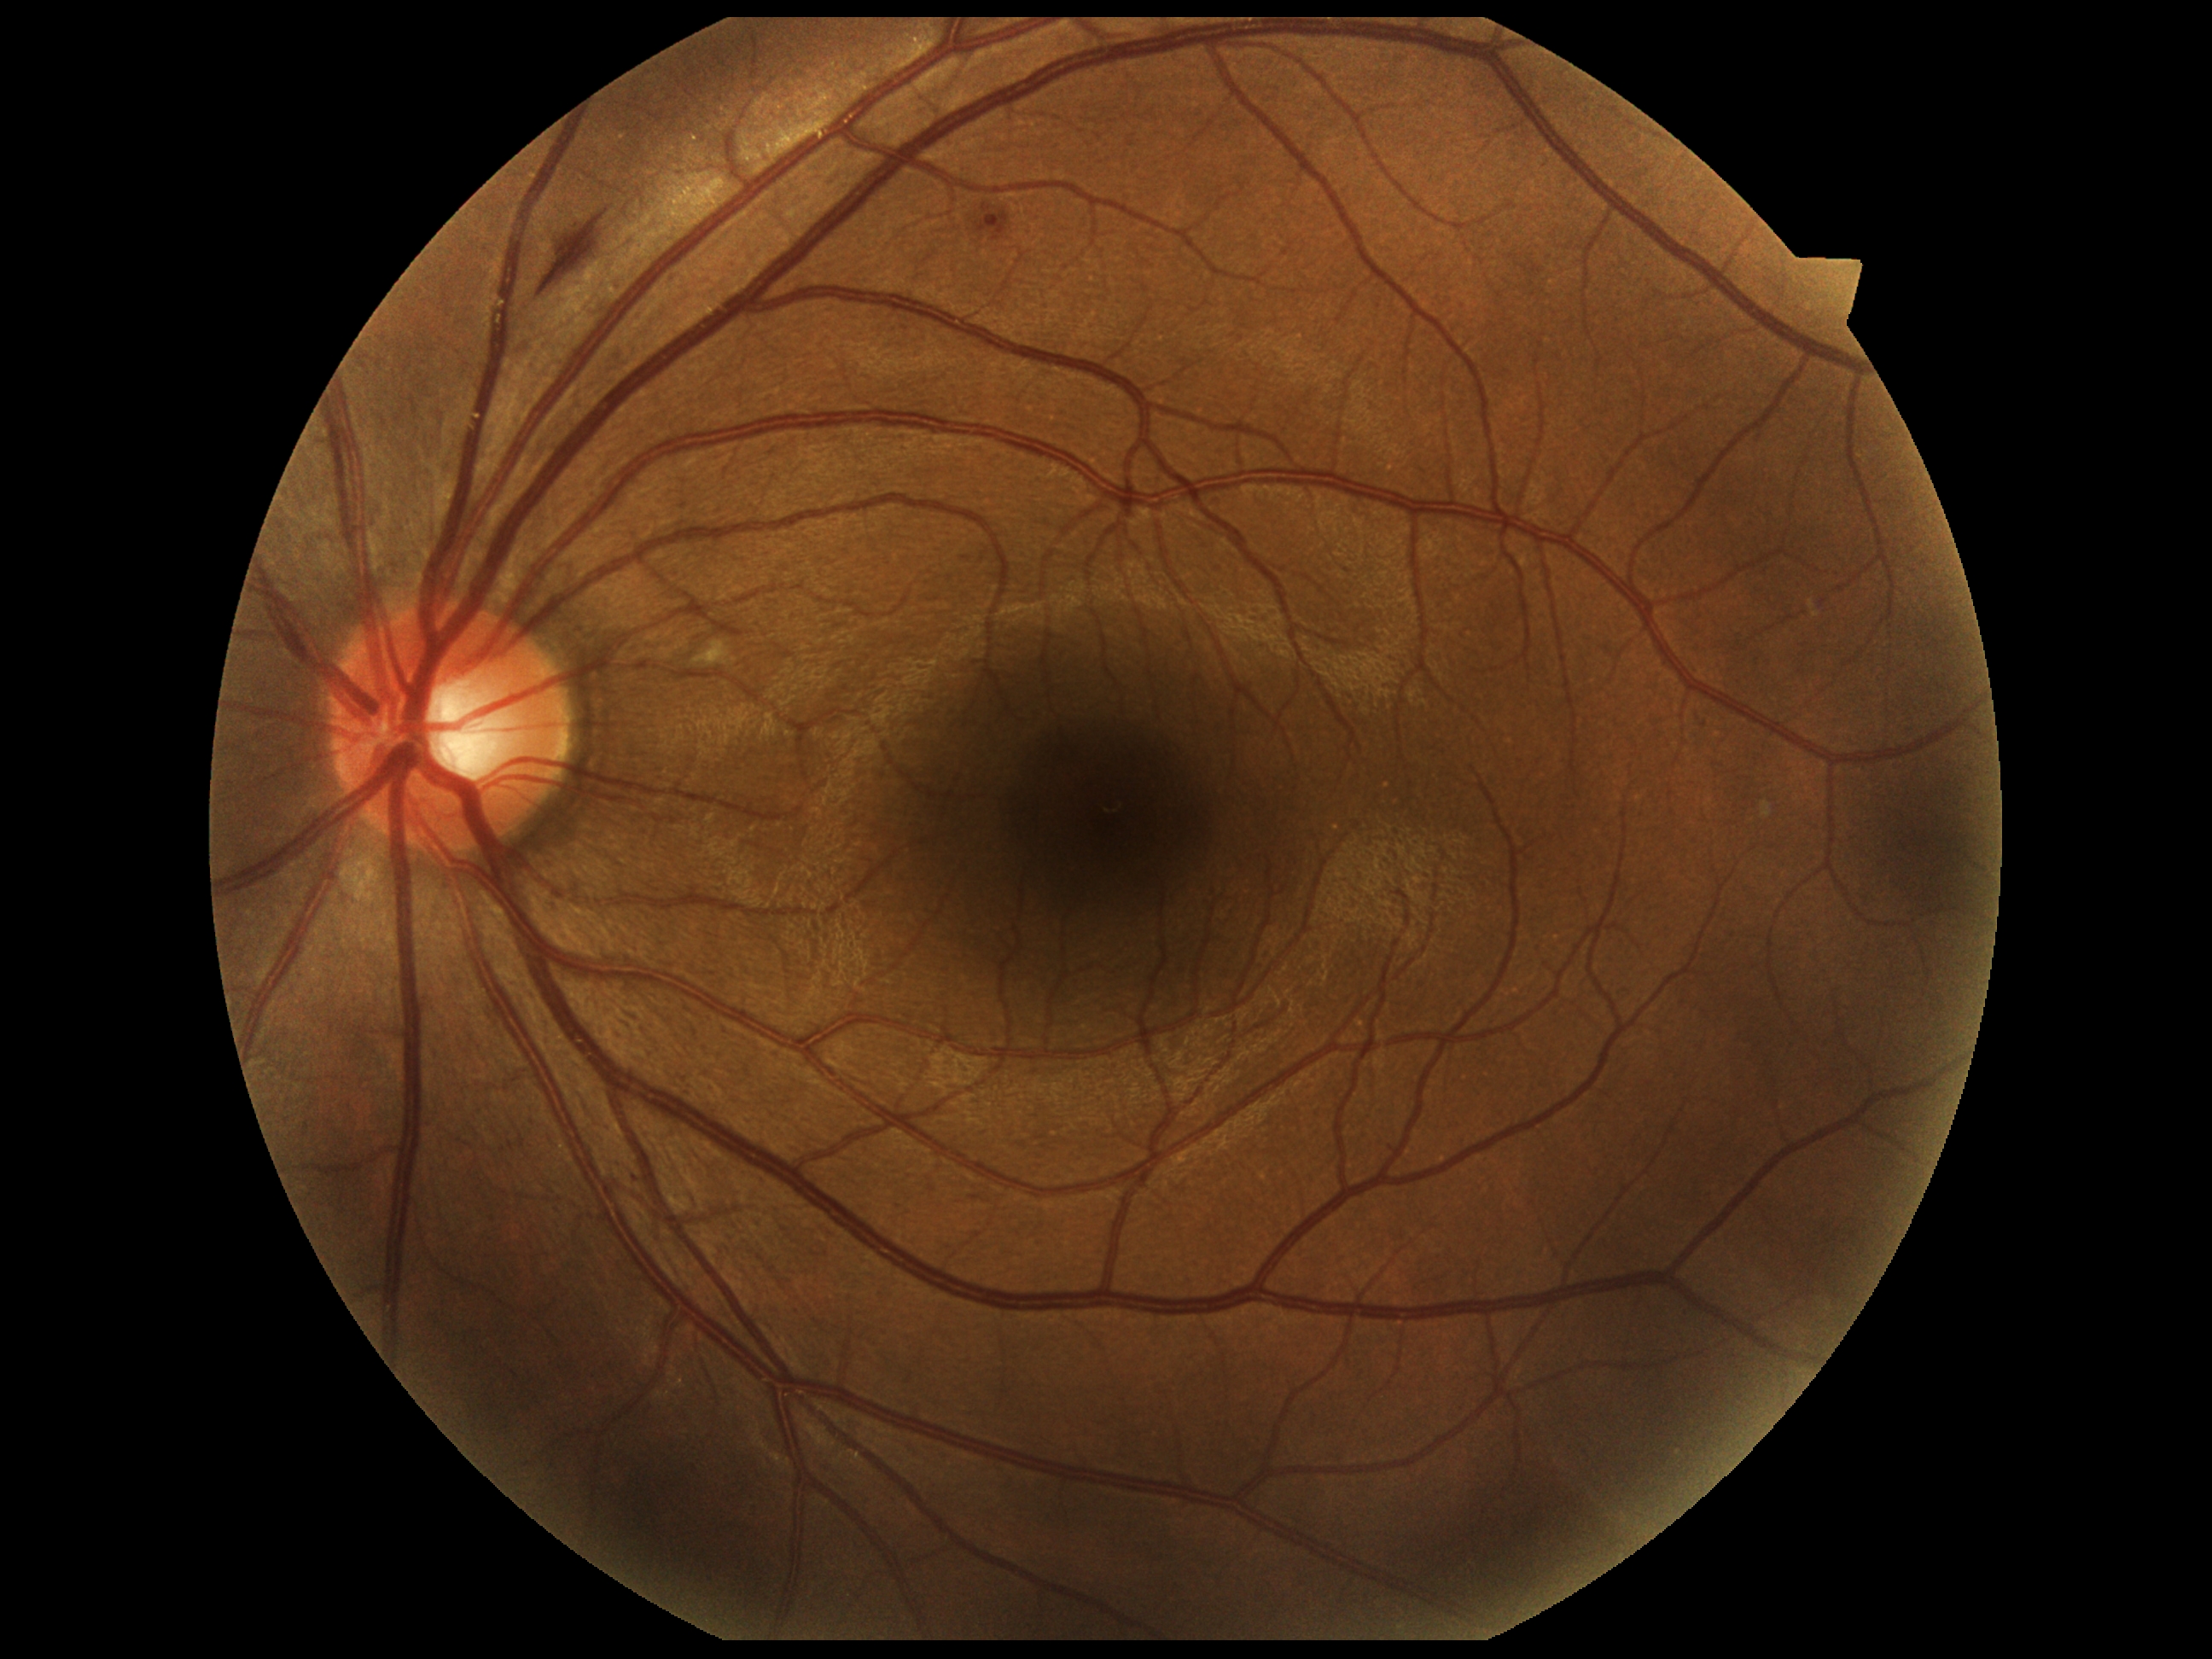 DR is moderate non-proliferative diabetic retinopathy (grade 2).